45° field of view; nonmydriatic; diabetic retinopathy graded by the modified Davis classification:
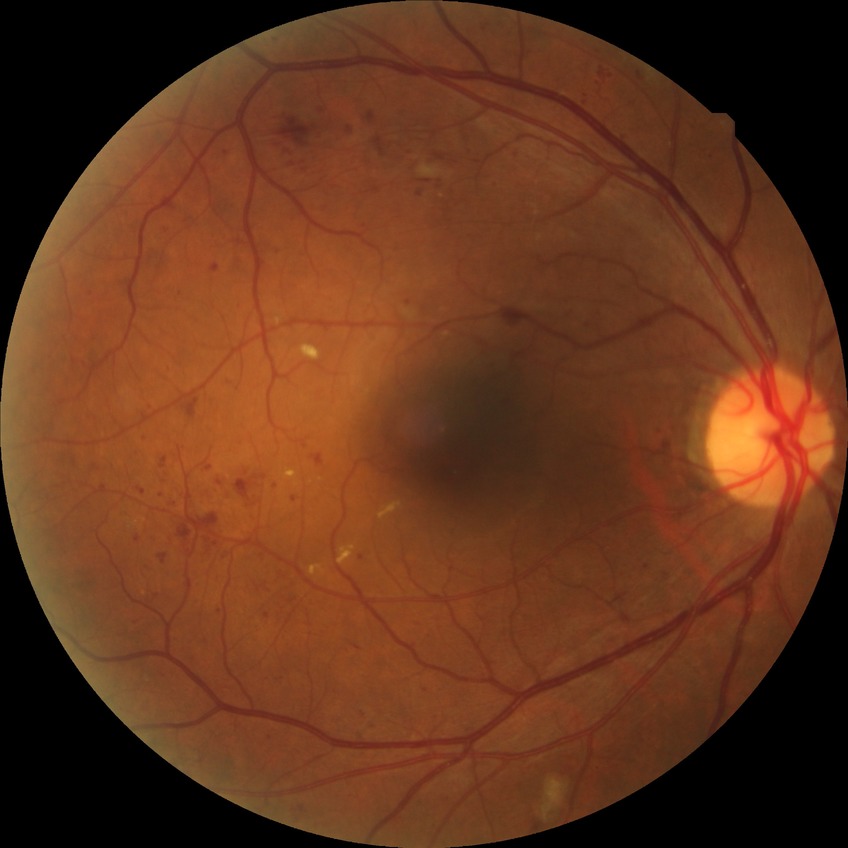
Diabetic retinopathy stage is pre-proliferative diabetic retinopathy.